Acquired with a NIDEK AFC-230: 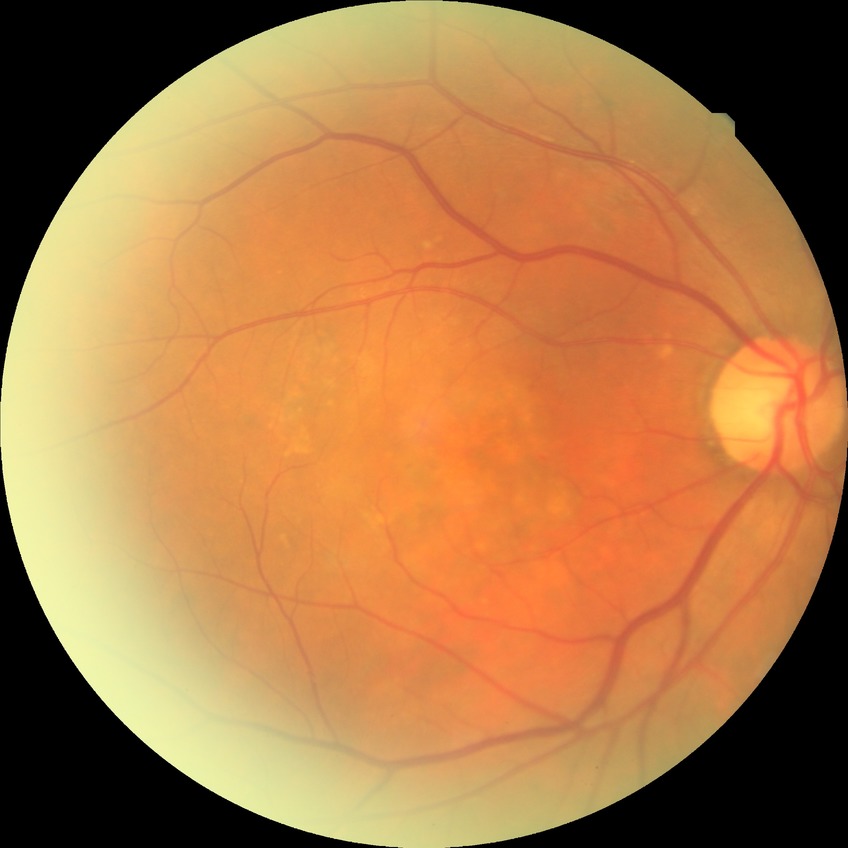

Diabetic retinopathy stage is no diabetic retinopathy.